640x480; wide-field fundus photograph of an infant: 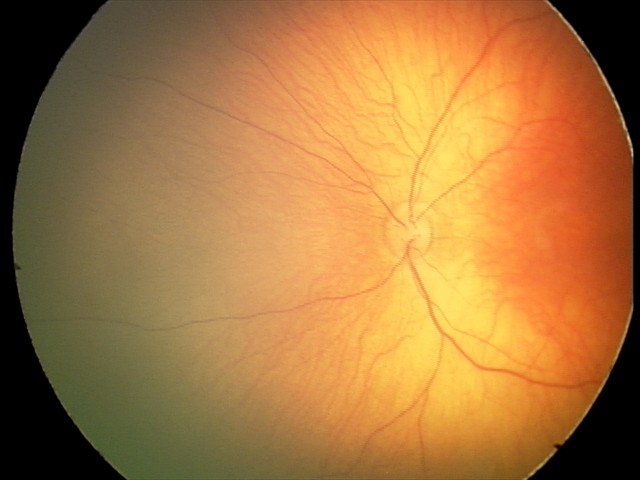
Screening examination consistent with retinal hemorrhages.